Posterior pole color fundus photograph
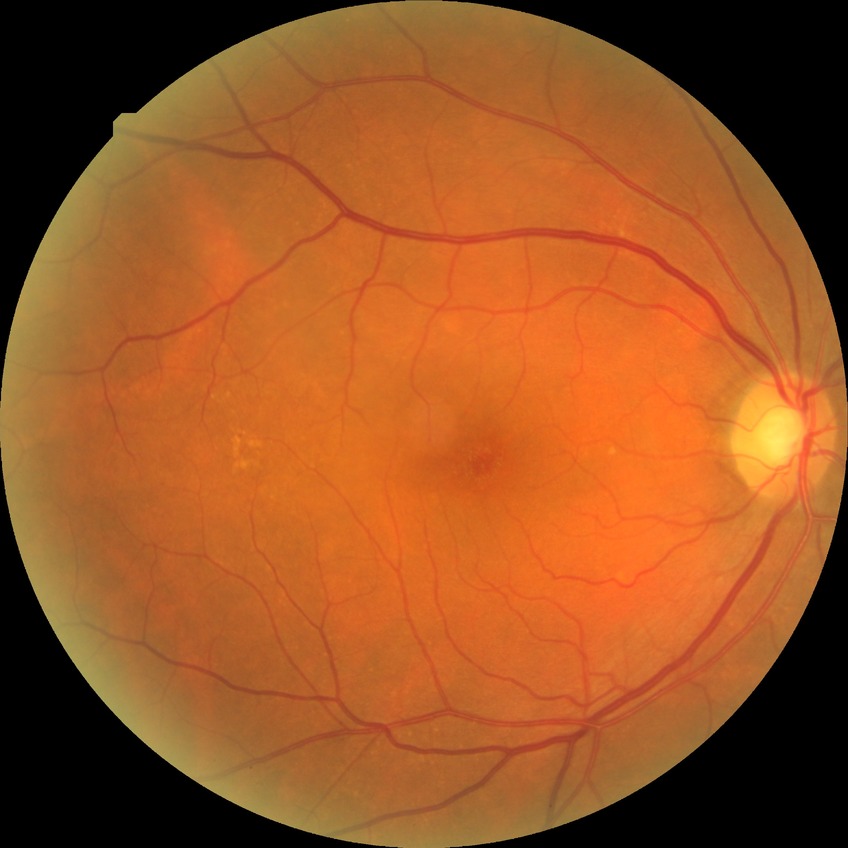
diabetic retinopathy (DR)=no diabetic retinopathy (NDR).